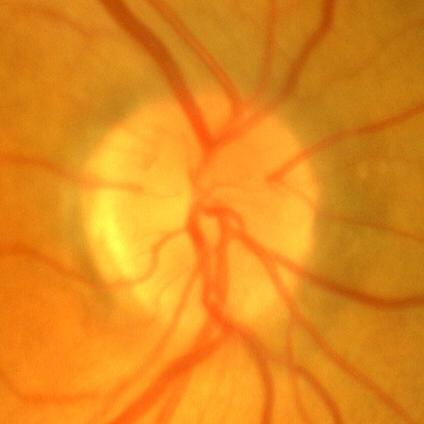

Optic disc appearance consistent with no evidence of glaucoma.